FOV: 45 degrees:
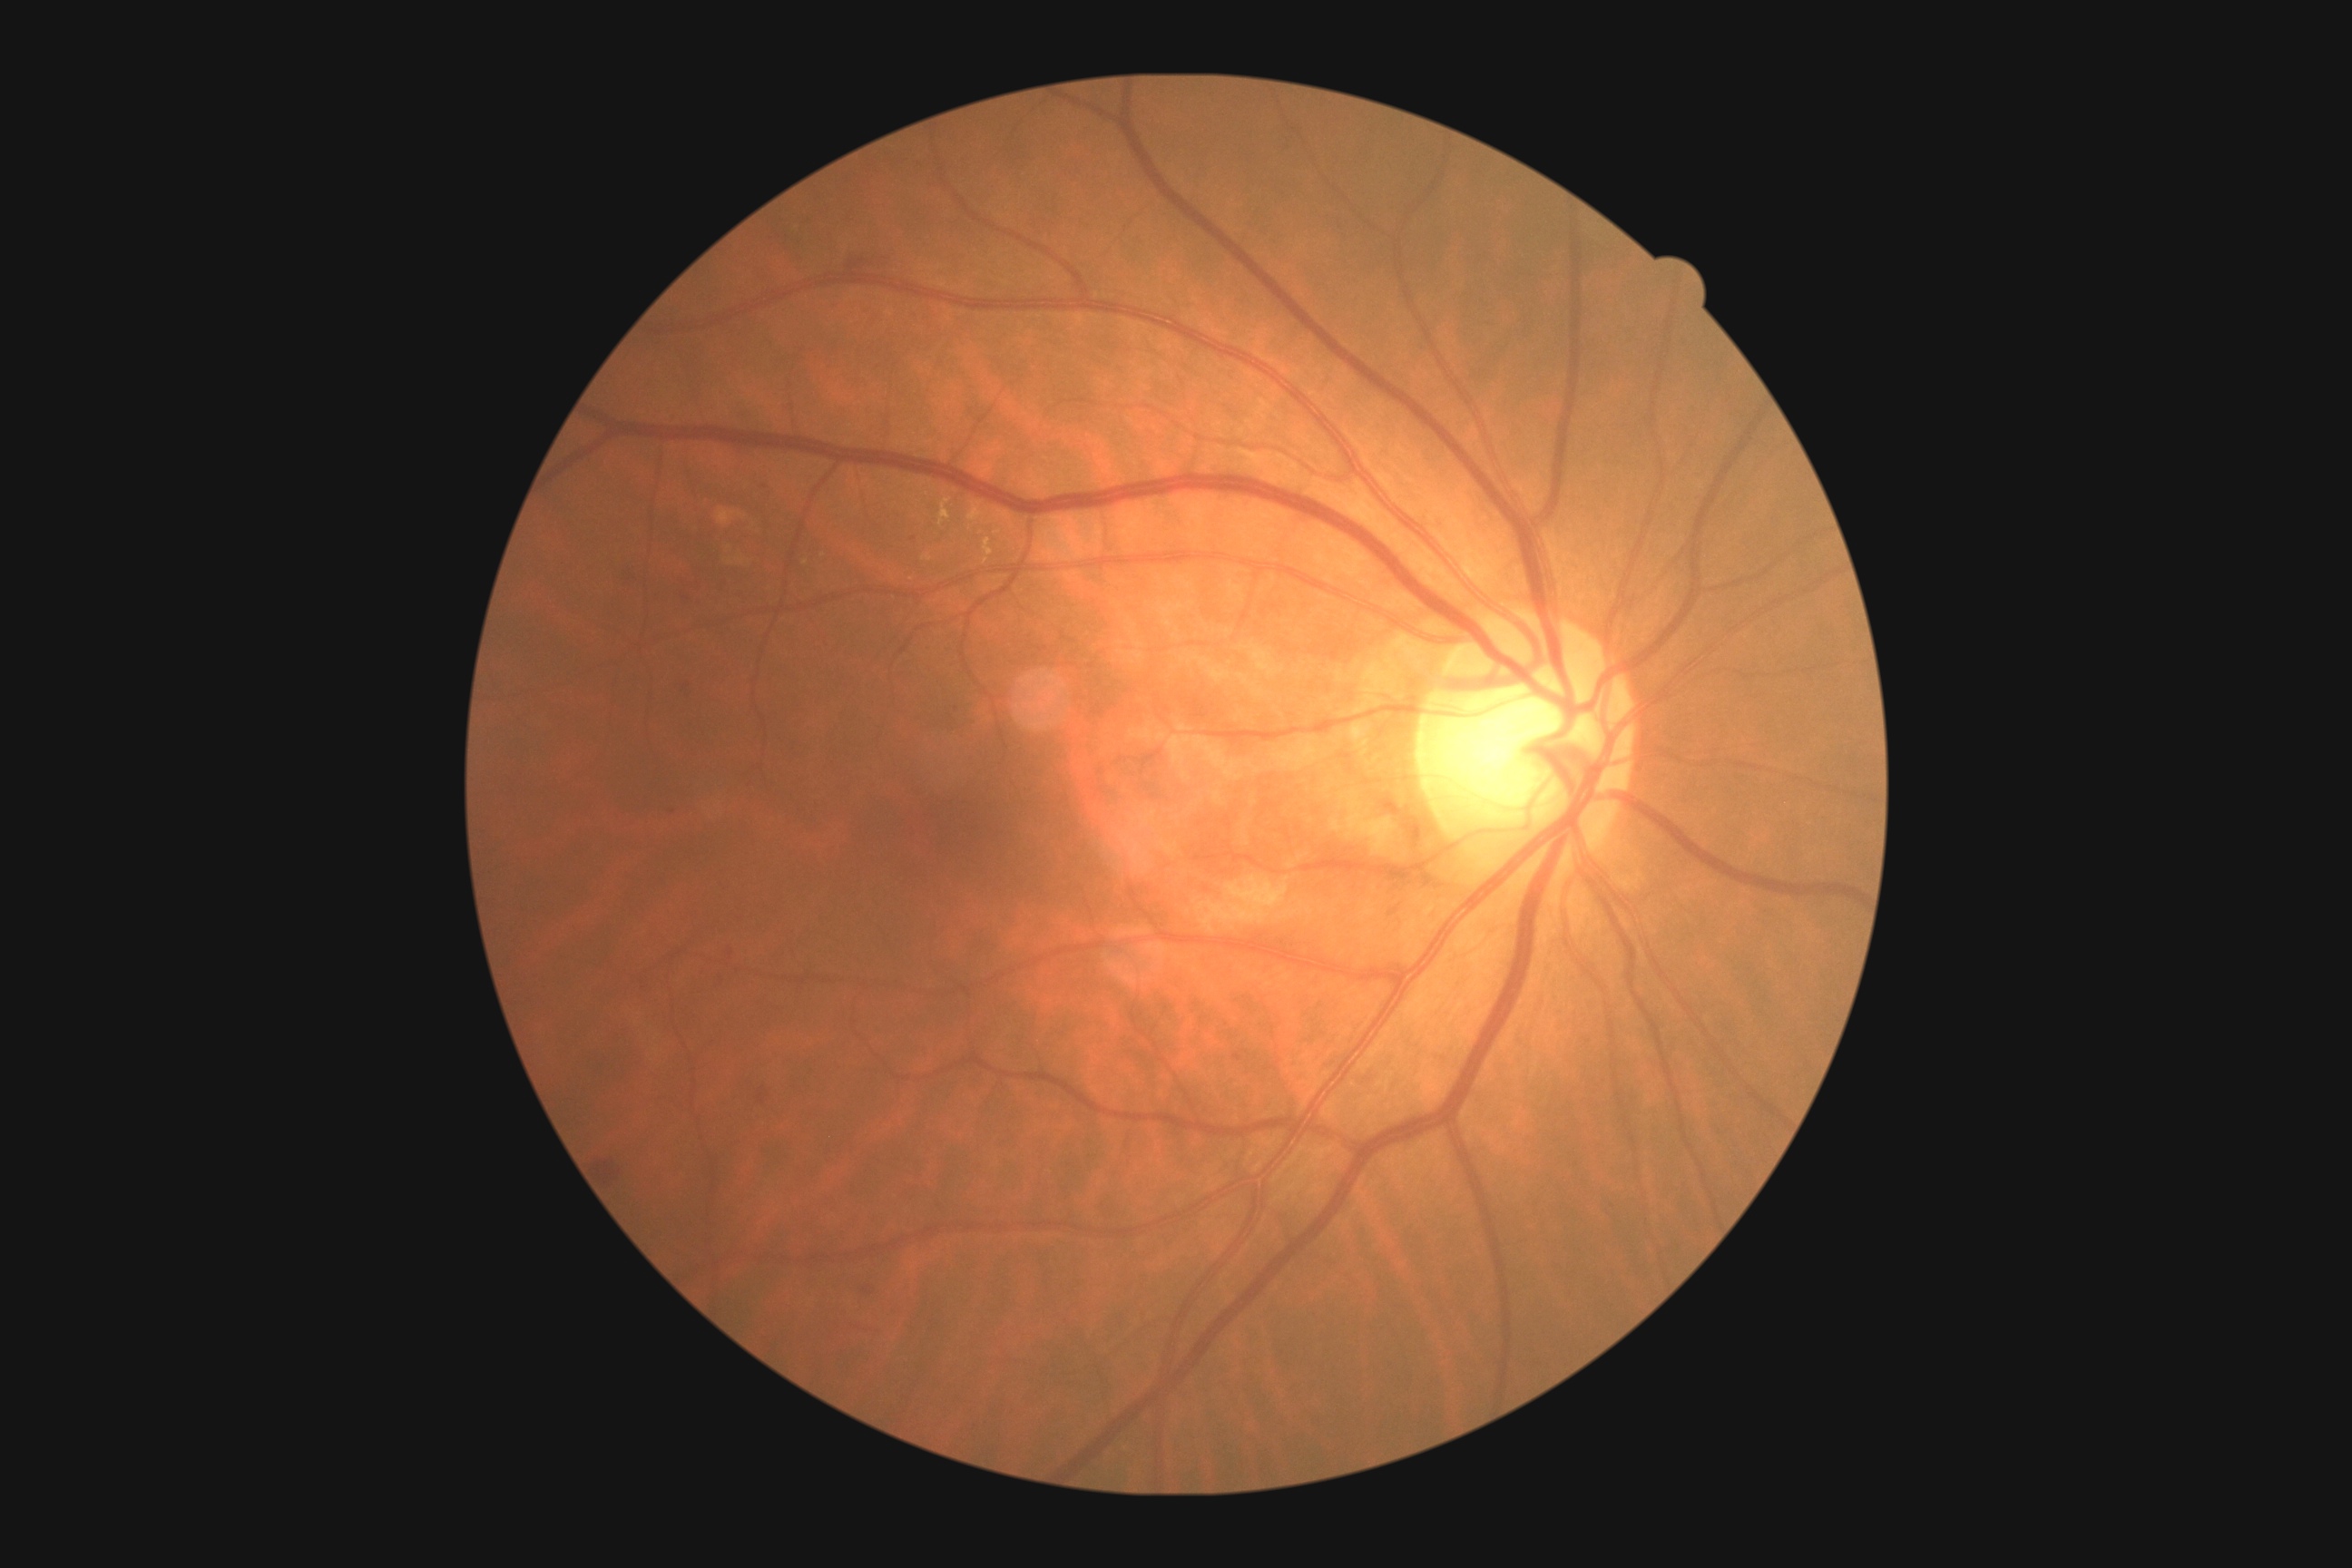

DR severity: grade 2 (moderate NPDR).